Visual field mean defect: 0.73 dB. Optic disc-centered. 30-degree field of view. Axial length 23.27 mm. IOP: 18 mmHg:
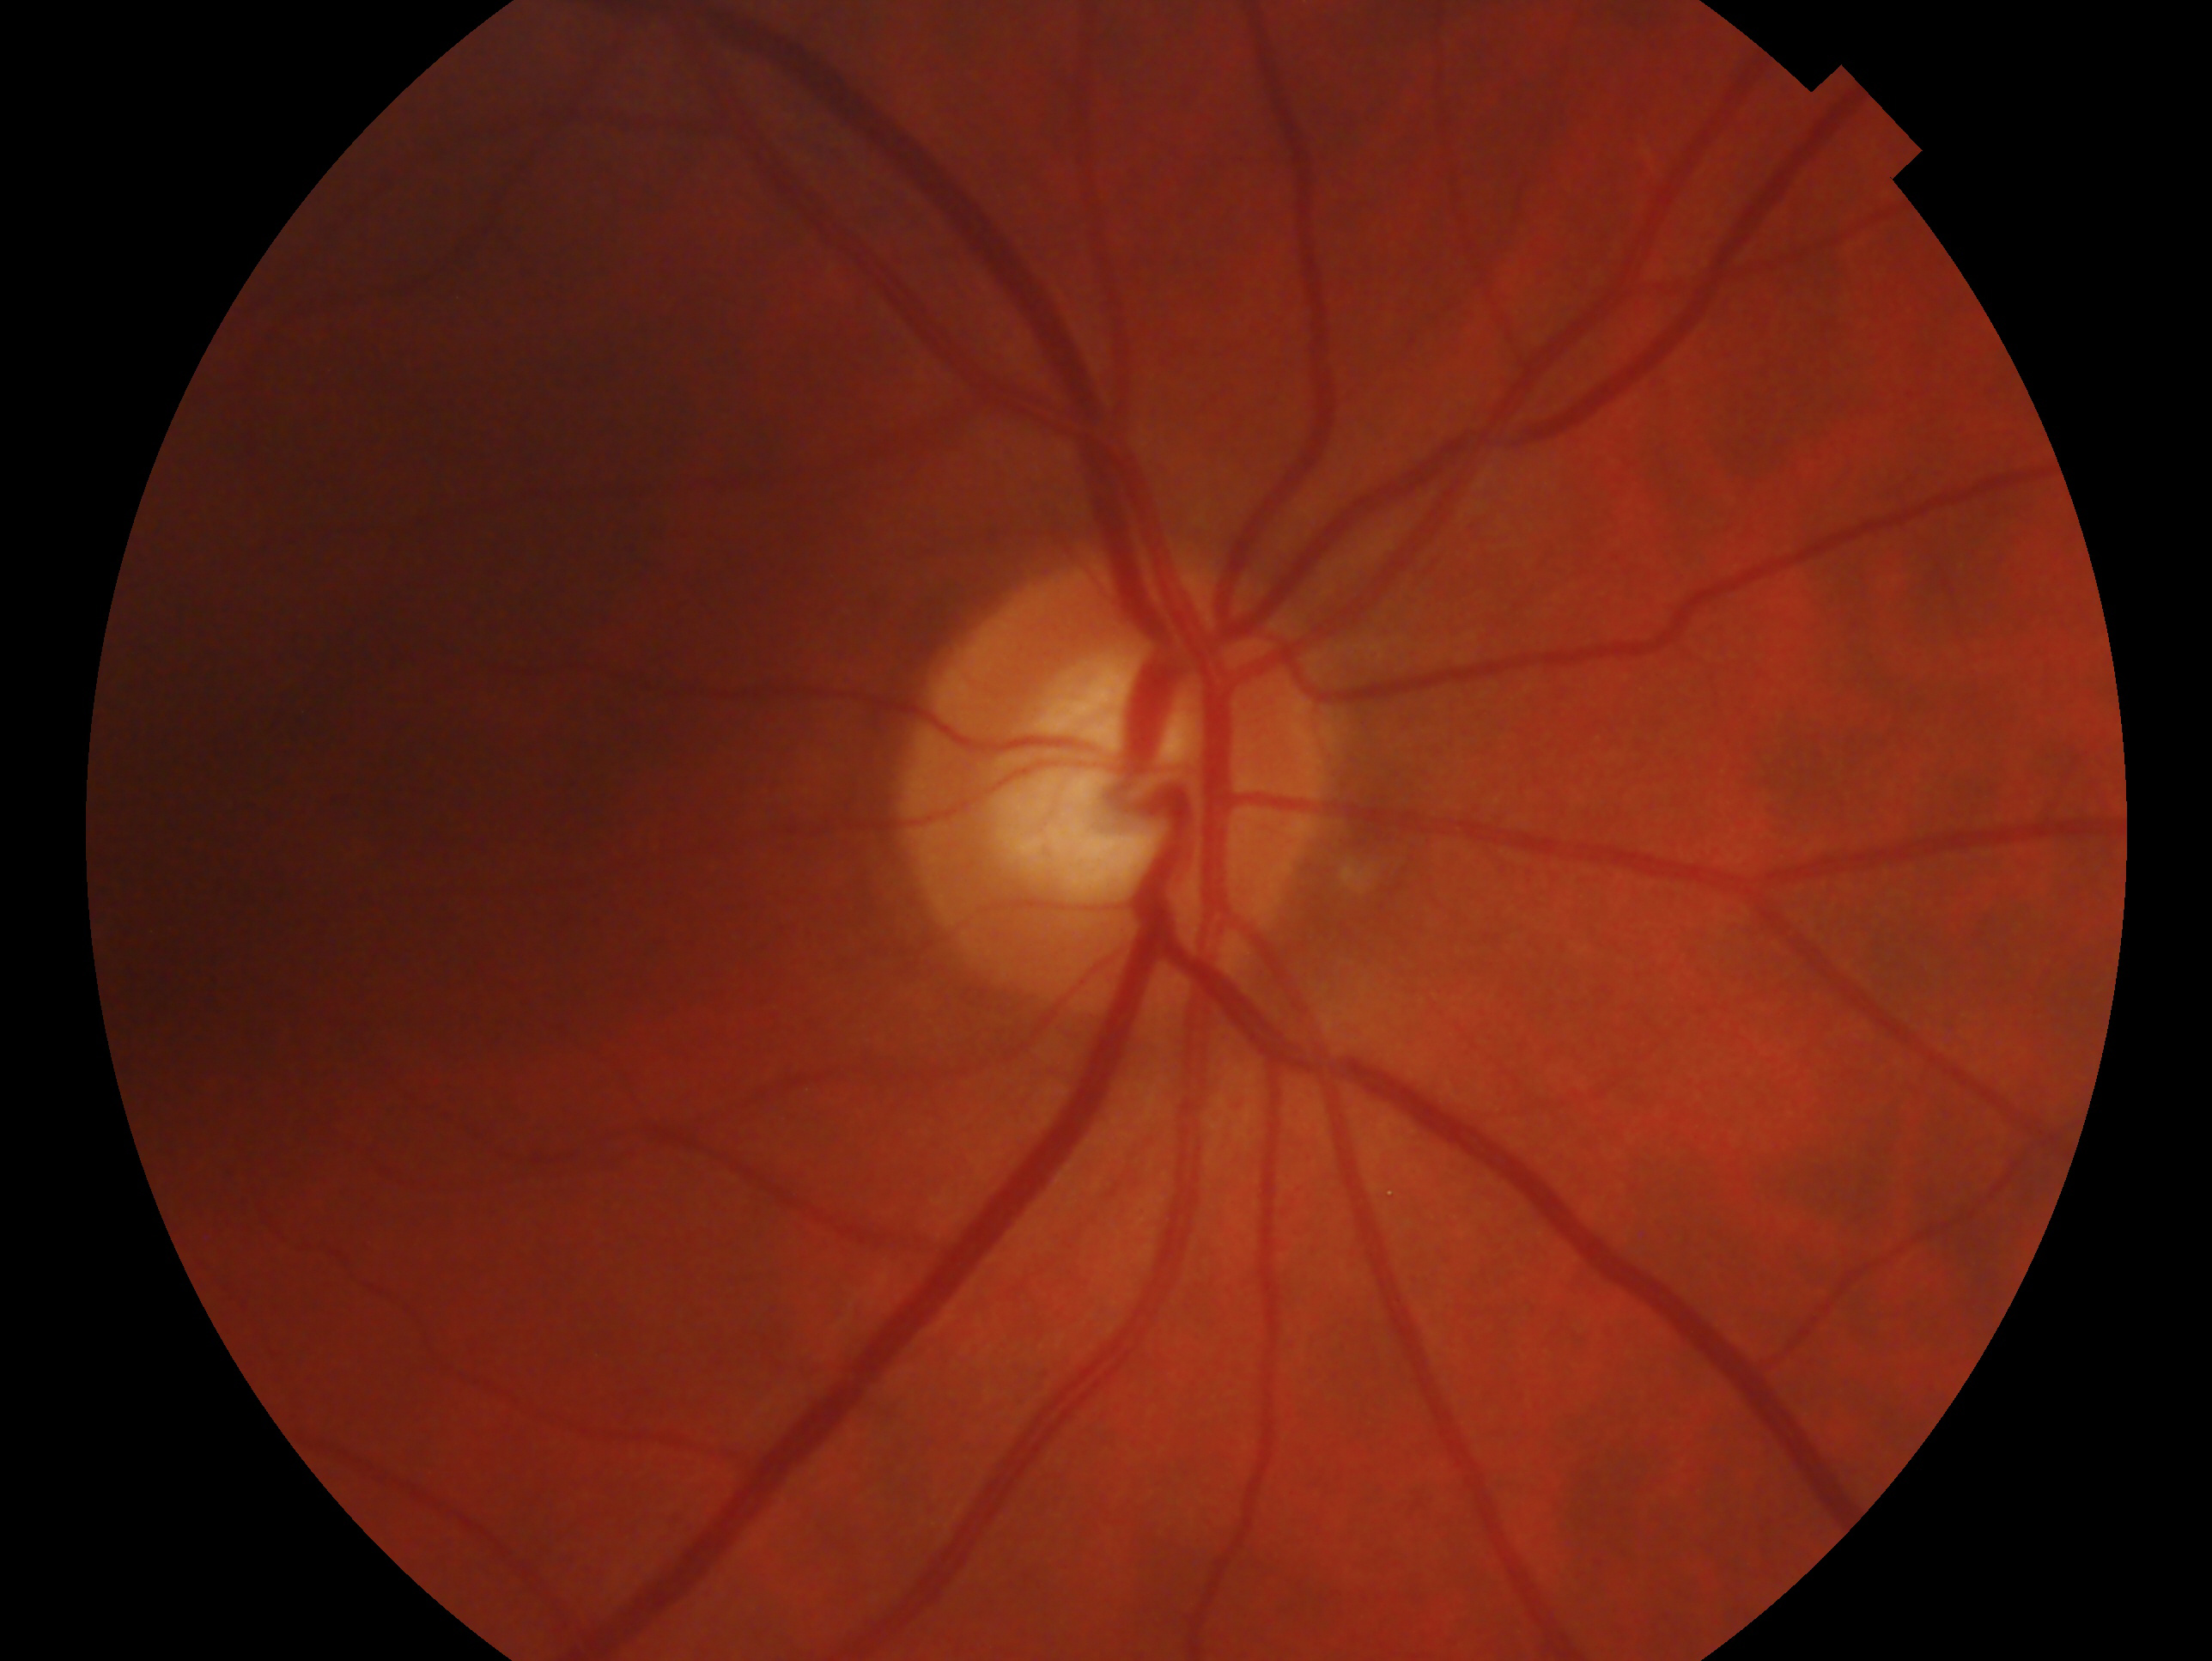

The image shows the right eye. Glaucoma status: glaucomatous optic neuropathy.